Fundus photo · captured on a Nidek AFC-330 fundus camera · cropped to the optic nerve head:
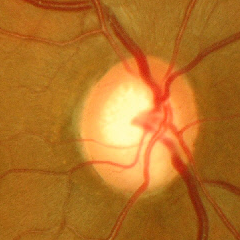

Diagnosis = advanced glaucomatous optic neuropathy.